CFP
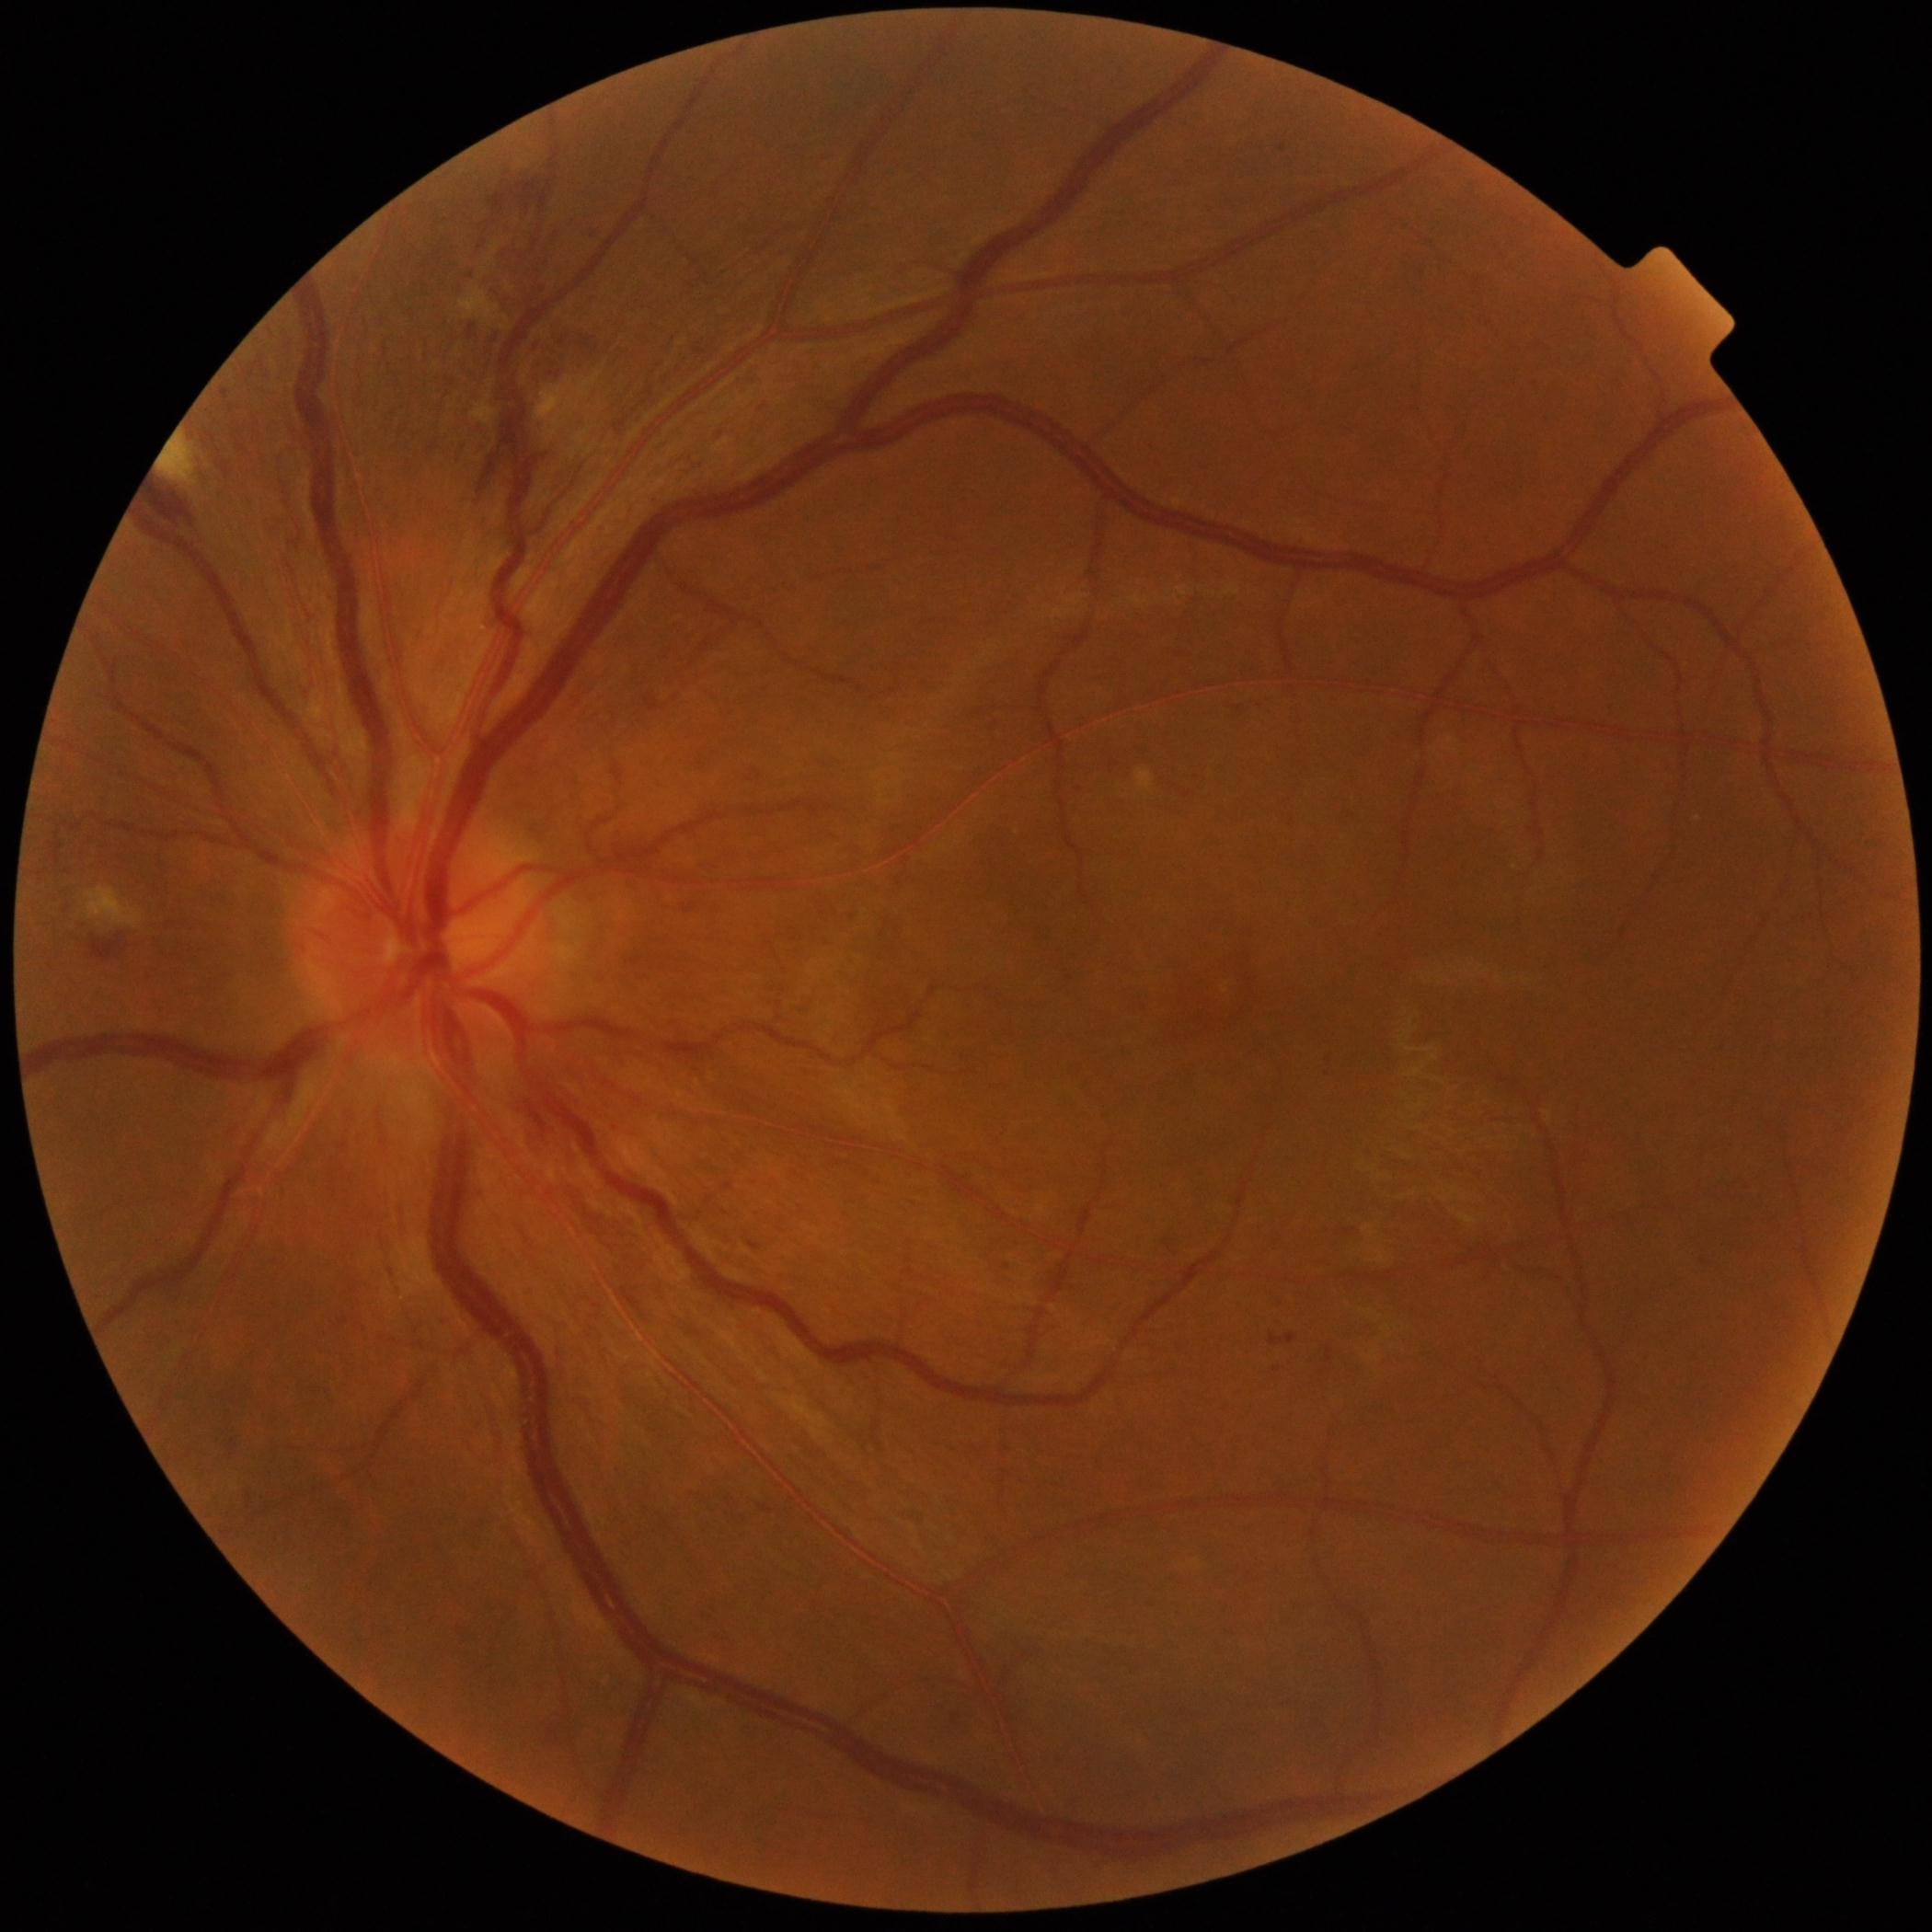

Retinopathy grade: moderate non-proliferative diabetic retinopathy (2).